Without pupil dilation:
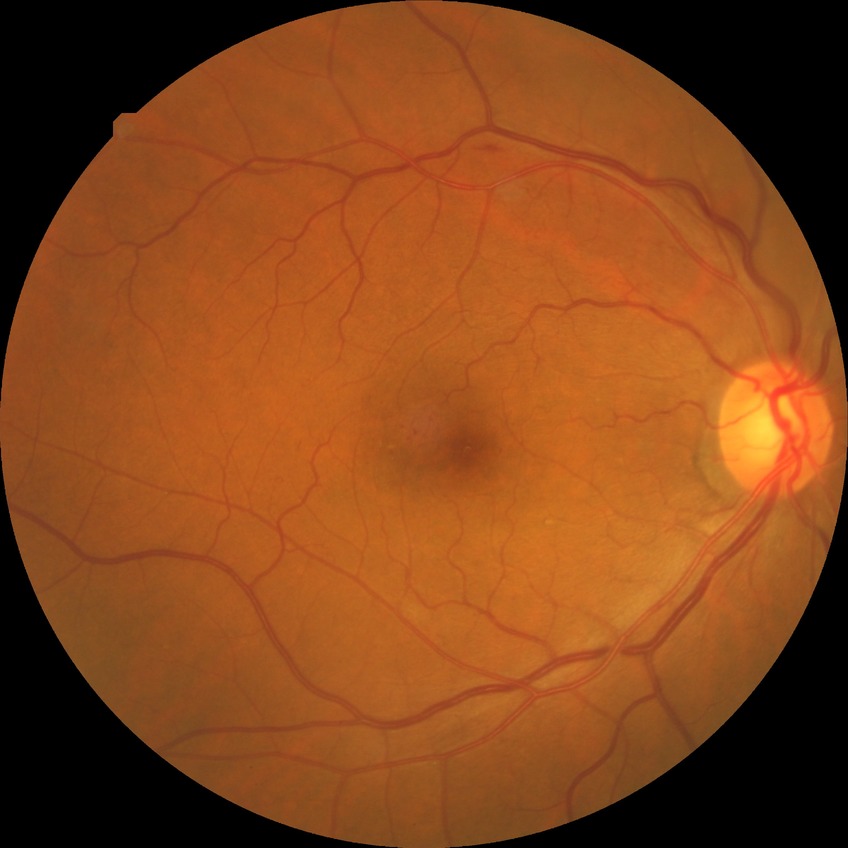
Diabetic retinopathy (DR) is SDR (simple diabetic retinopathy).